848 by 848 pixels: 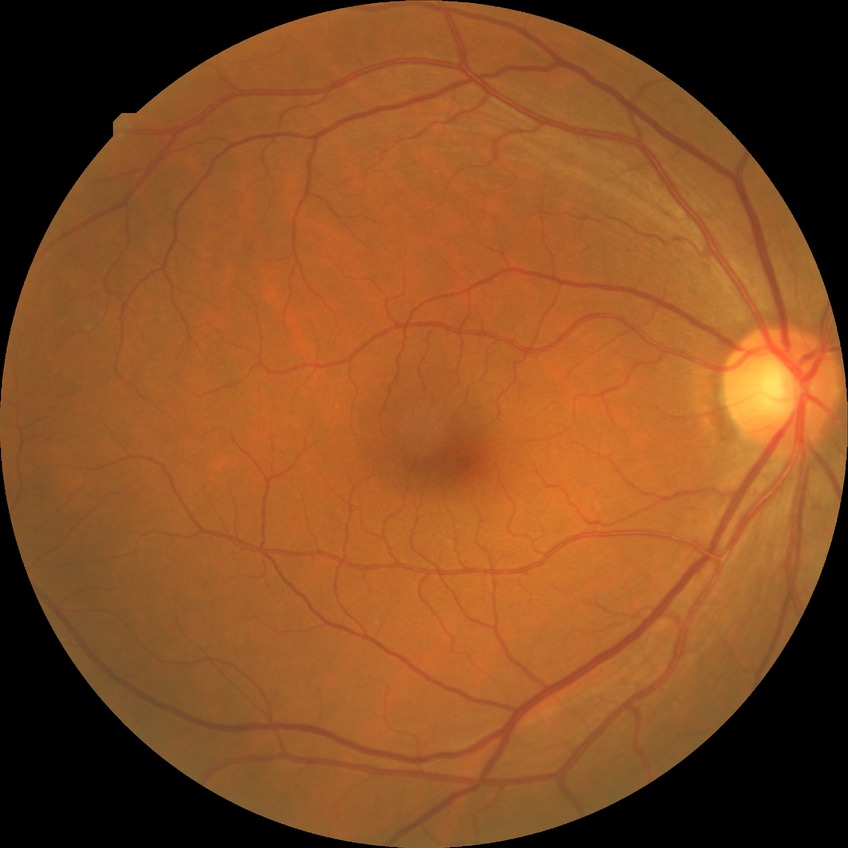 Diabetic retinopathy severity: no diabetic retinopathy.